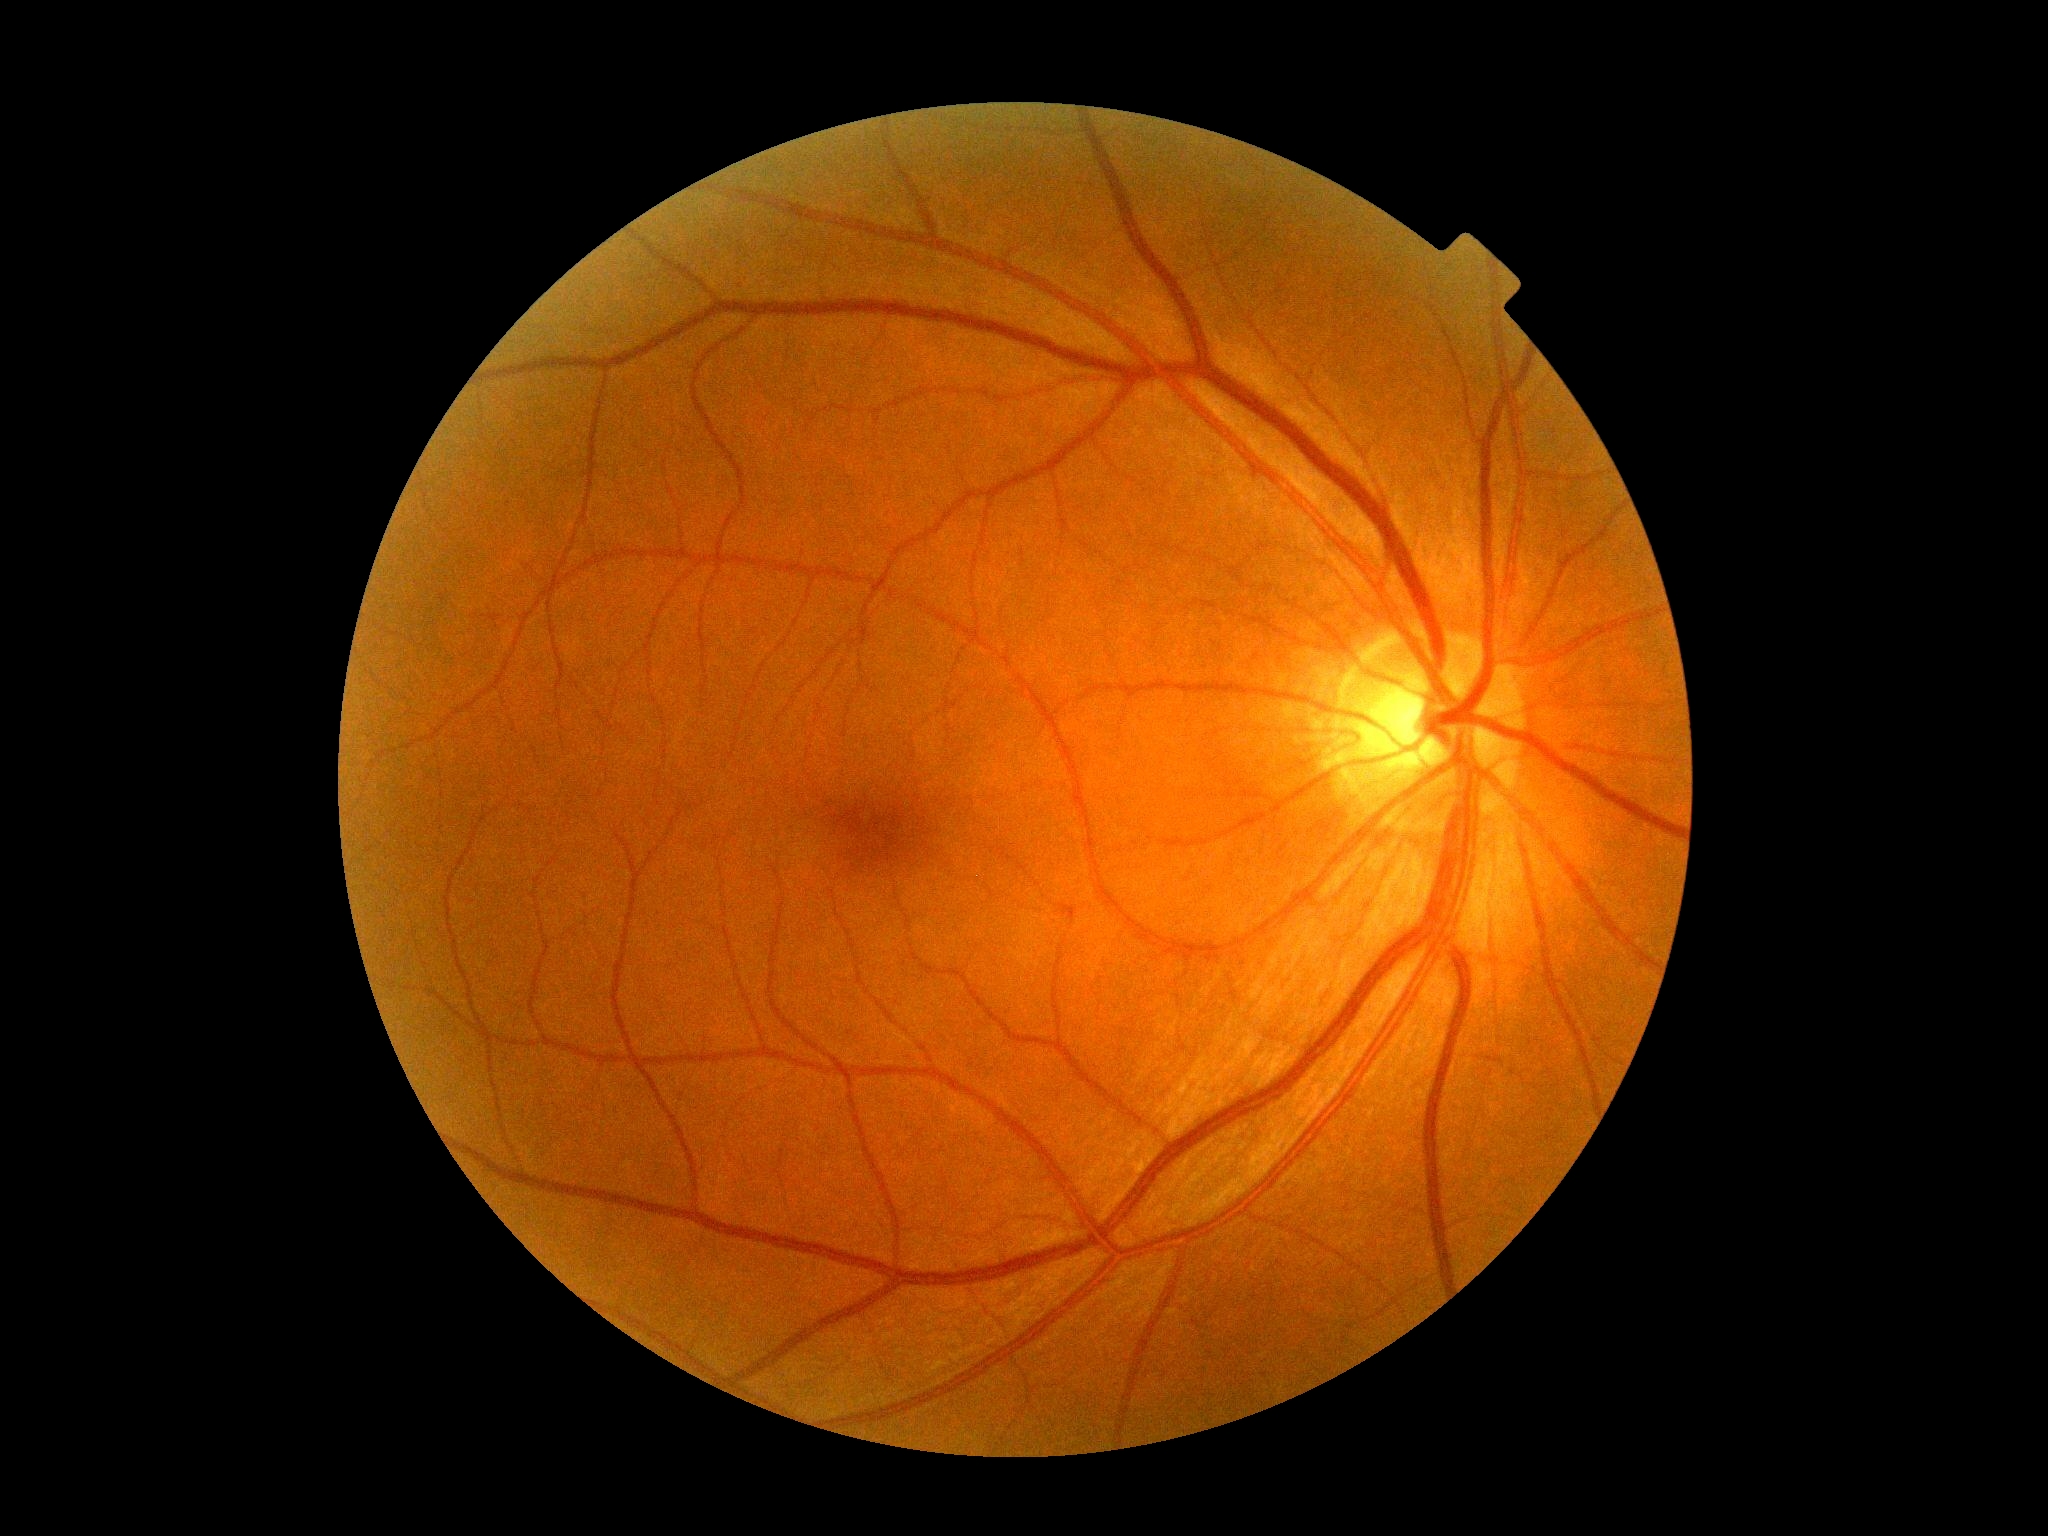 dr_grade: 0 (no apparent retinopathy)